45° field of view, retinal fundus photograph: 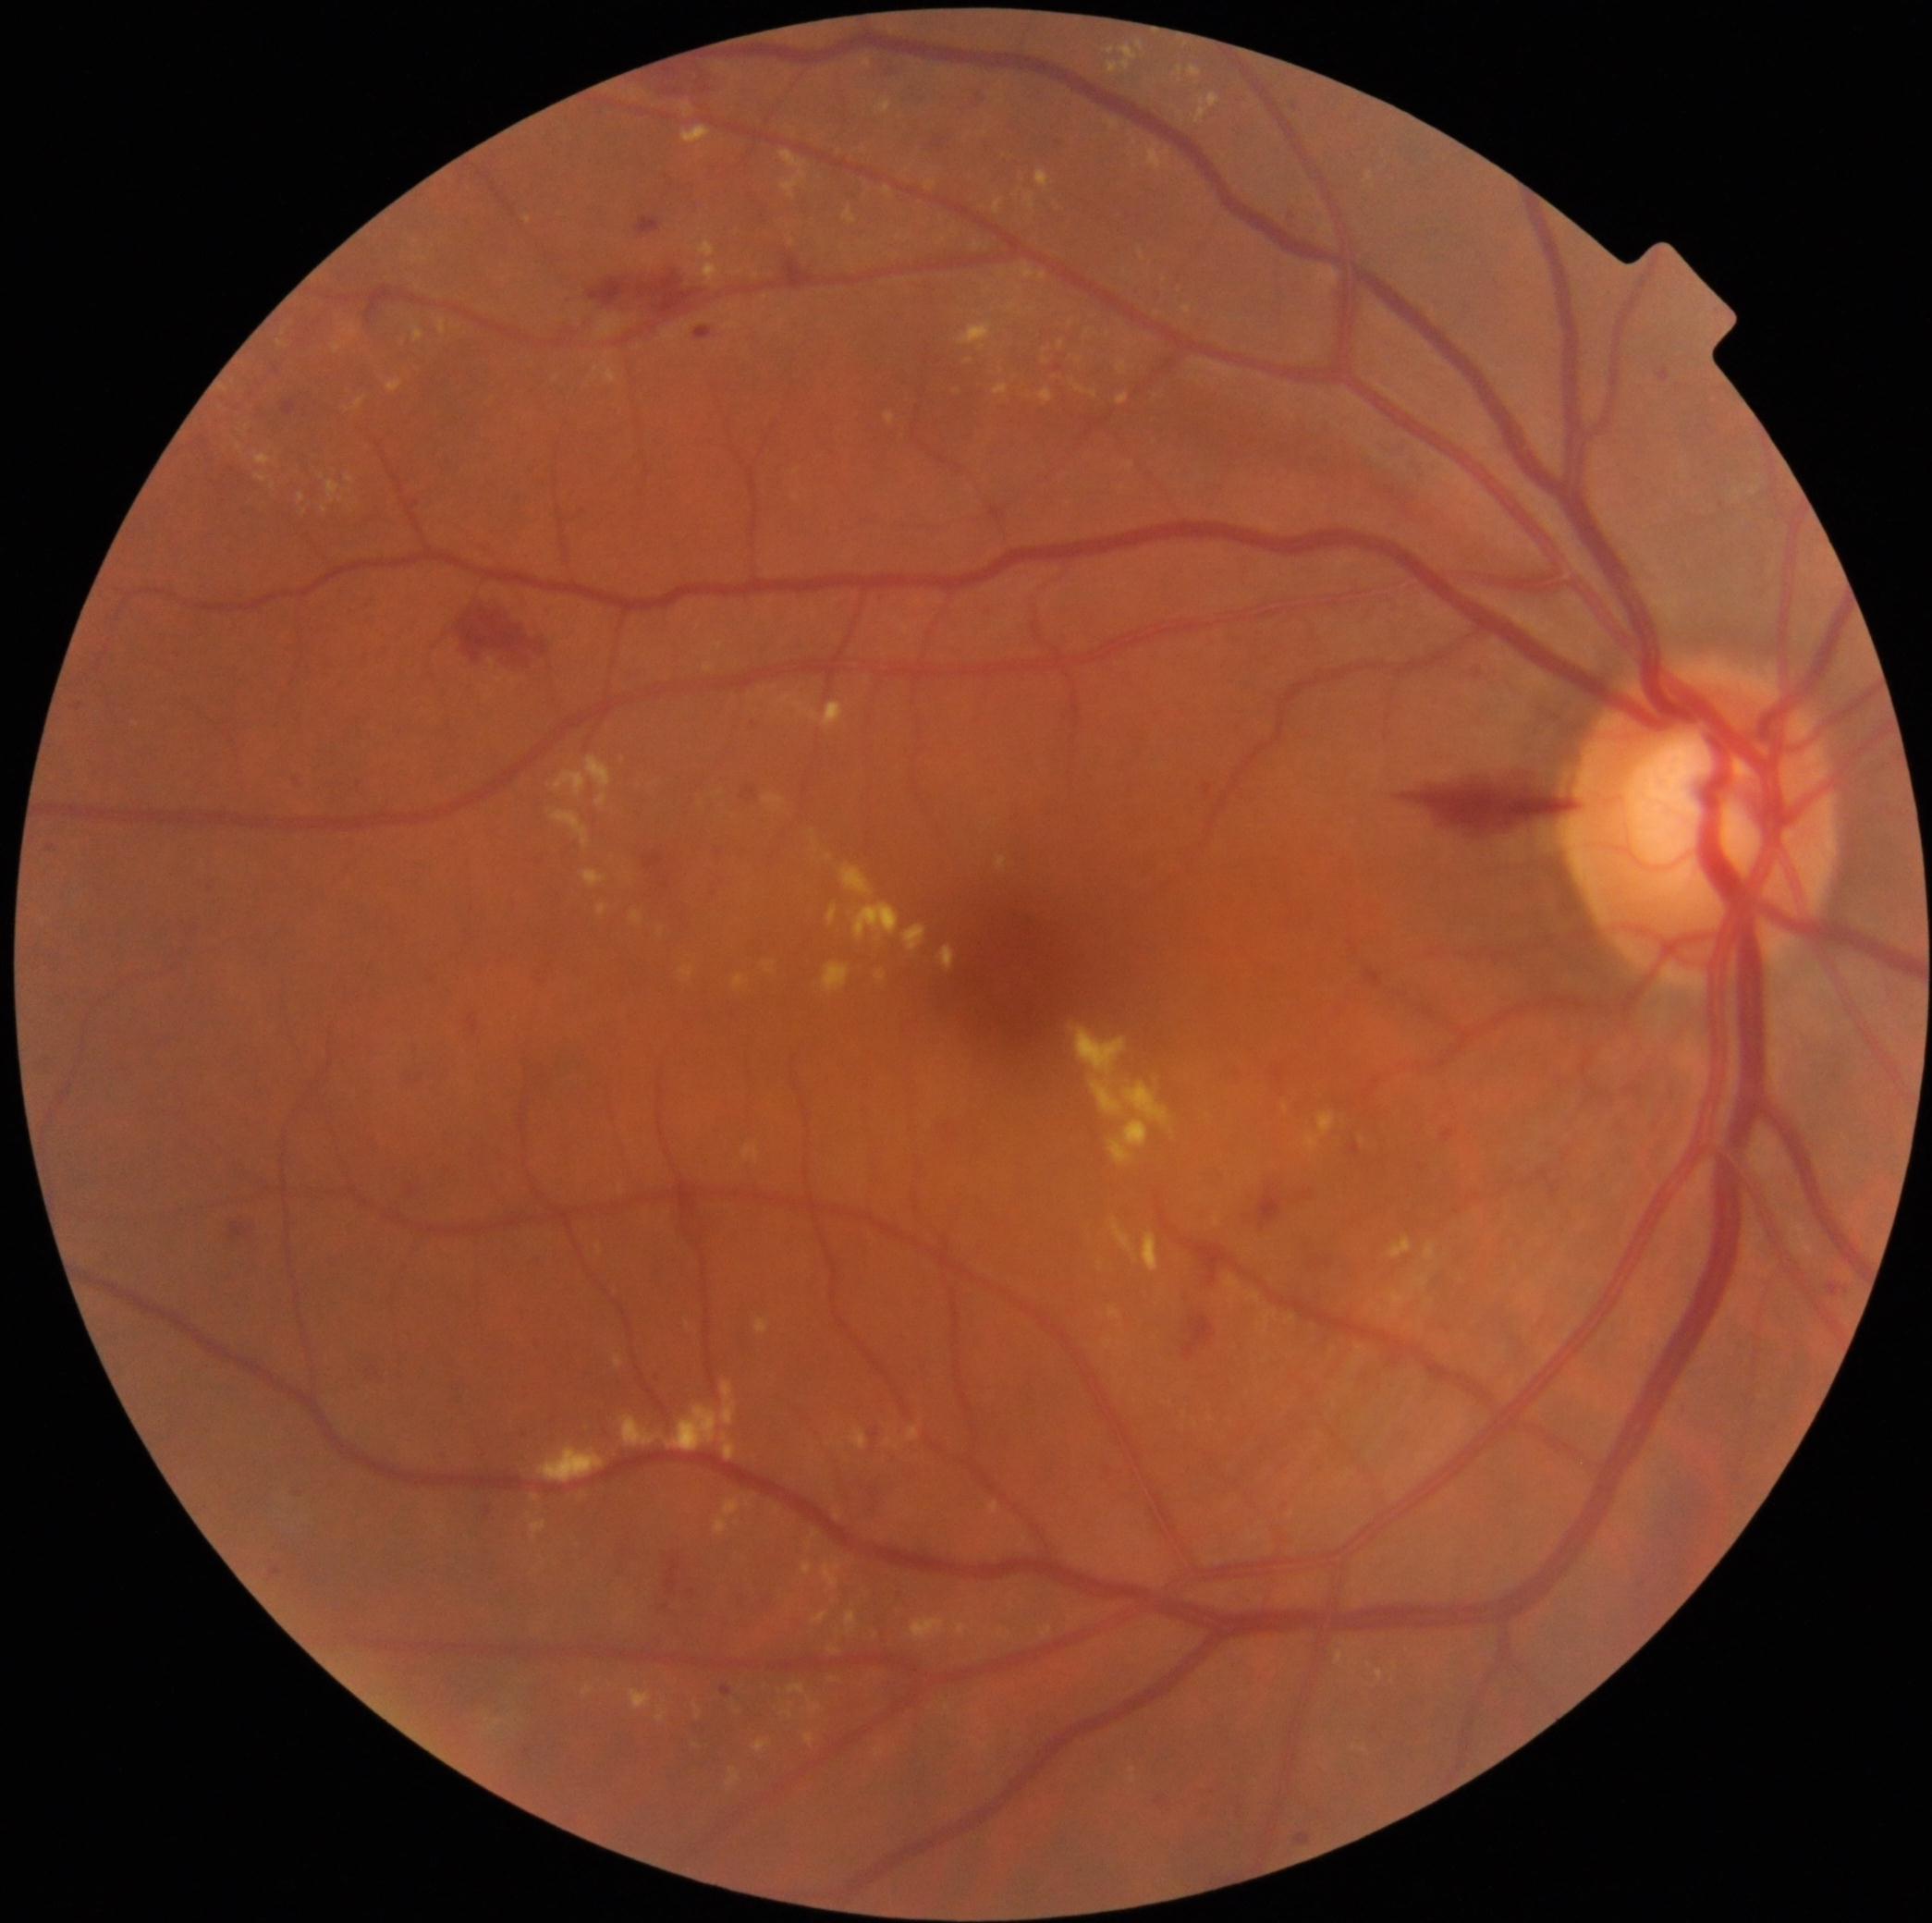

Diabetic retinopathy (DR) is 2/4.
Microaneurysms (MAs) are present, including at {"left": 1351, "top": 1143, "right": 1361, "bottom": 1154}; {"left": 696, "top": 328, "right": 713, "bottom": 339}; {"left": 919, "top": 92, "right": 928, "bottom": 102}; {"left": 1660, "top": 370, "right": 1669, "bottom": 383}; {"left": 1828, "top": 1283, "right": 1844, "bottom": 1296}; {"left": 1054, "top": 140, "right": 1063, "bottom": 149}; {"left": 662, "top": 876, "right": 671, "bottom": 890}; {"left": 711, "top": 884, "right": 718, "bottom": 892}; {"left": 1205, "top": 785, "right": 1213, "bottom": 796}; {"left": 413, "top": 1072, "right": 424, "bottom": 1086}; {"left": 467, "top": 1015, "right": 479, "bottom": 1034}.
Small MAs near Point(753, 724); Point(80, 707); Point(50, 848); Point(523, 1429); Point(1059, 369); Point(693, 1593).
Hard exudates (EXs) are present, including at {"left": 332, "top": 343, "right": 346, "bottom": 355}; {"left": 587, "top": 757, "right": 613, "bottom": 807}; {"left": 722, "top": 1382, "right": 737, "bottom": 1427}; {"left": 812, "top": 1530, "right": 819, "bottom": 1539}; {"left": 1107, "top": 1307, "right": 1121, "bottom": 1318}; {"left": 630, "top": 1689, "right": 653, "bottom": 1709}; {"left": 1376, "top": 1669, "right": 1383, "bottom": 1682}; {"left": 1179, "top": 67, "right": 1182, "bottom": 76}; {"left": 666, "top": 1404, "right": 720, "bottom": 1451}; {"left": 1040, "top": 388, "right": 1054, "bottom": 403}; {"left": 952, "top": 1622, "right": 975, "bottom": 1636}; {"left": 838, "top": 1442, "right": 846, "bottom": 1448}; {"left": 1107, "top": 48, "right": 1115, "bottom": 55}; {"left": 1118, "top": 394, "right": 1129, "bottom": 405}; {"left": 1425, "top": 1242, "right": 1437, "bottom": 1260}.
Small EXs near Point(1136, 144); Point(696, 239); Point(989, 292); Point(1265, 1362).